Intraocular pressure 16 mmHg by pneumatic tonometry; axial length: 23.22 mm; pachymetry 538 µm; gender: F; 41-year-old patient; refractive error: -1.25 -0.25 × 180°; 30-degree field of view: 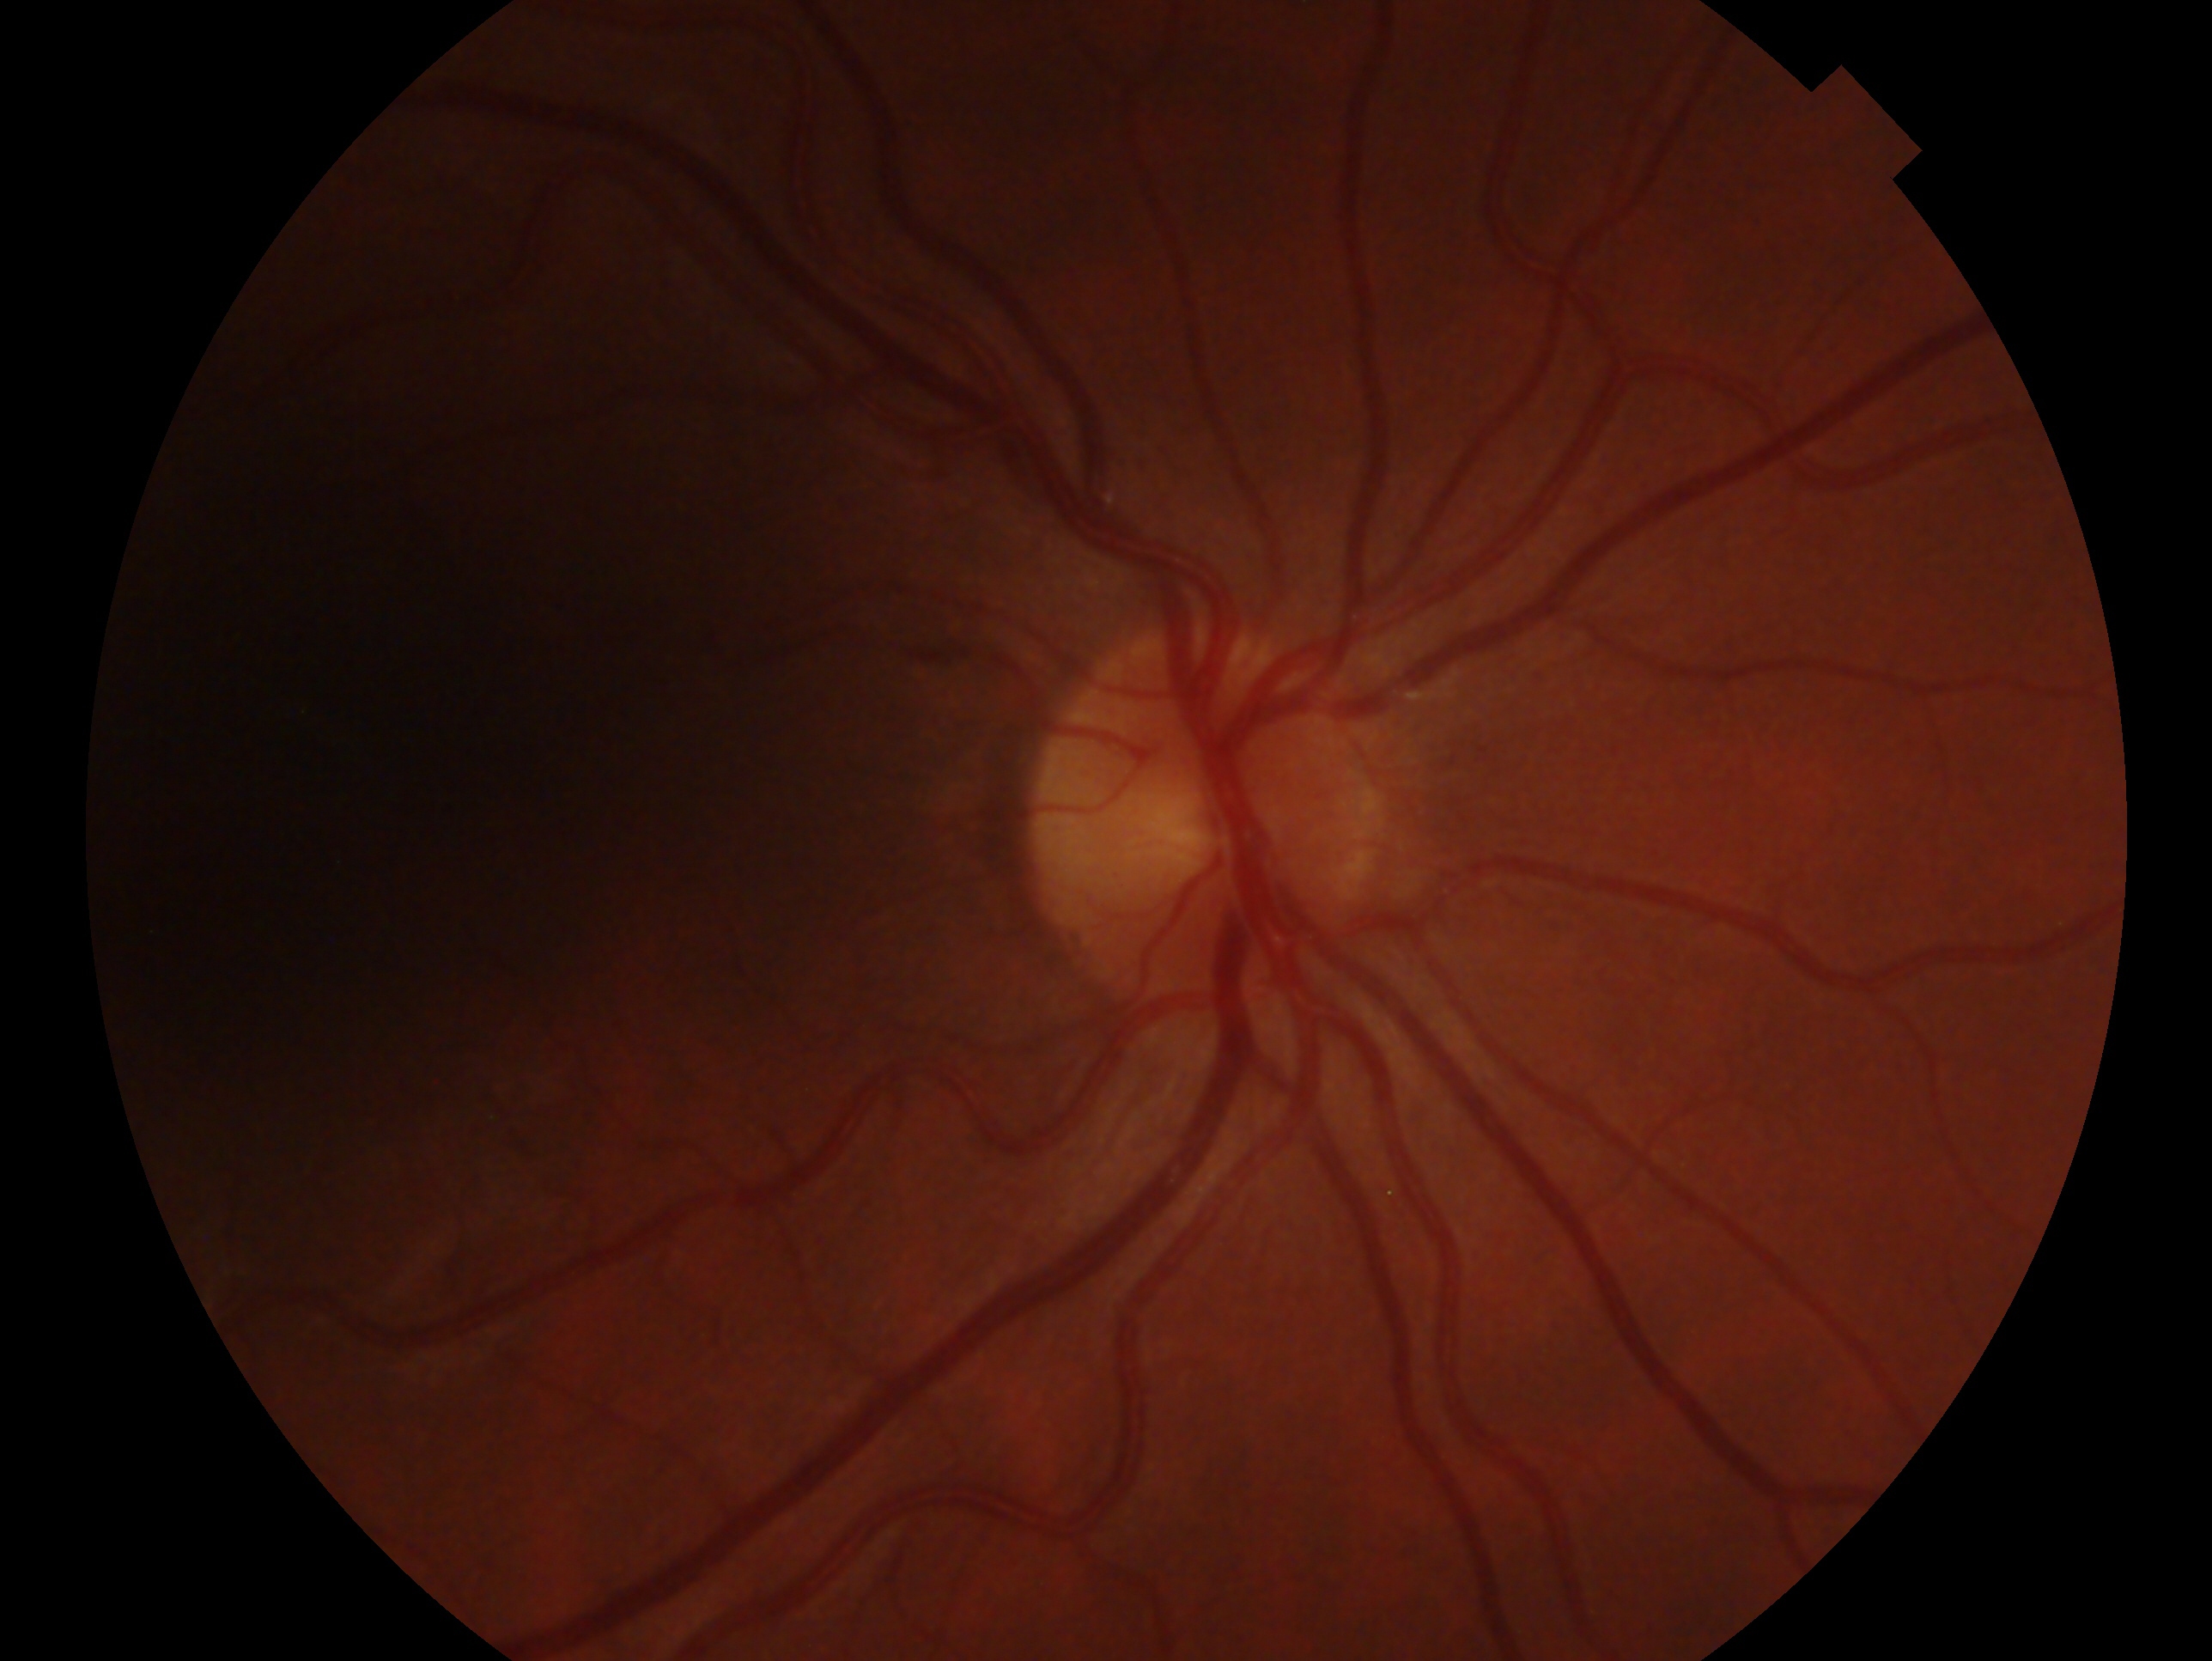

Diagnosis — no evidence of glaucoma. This is the OD.